CFP. FOV: 45 degrees.
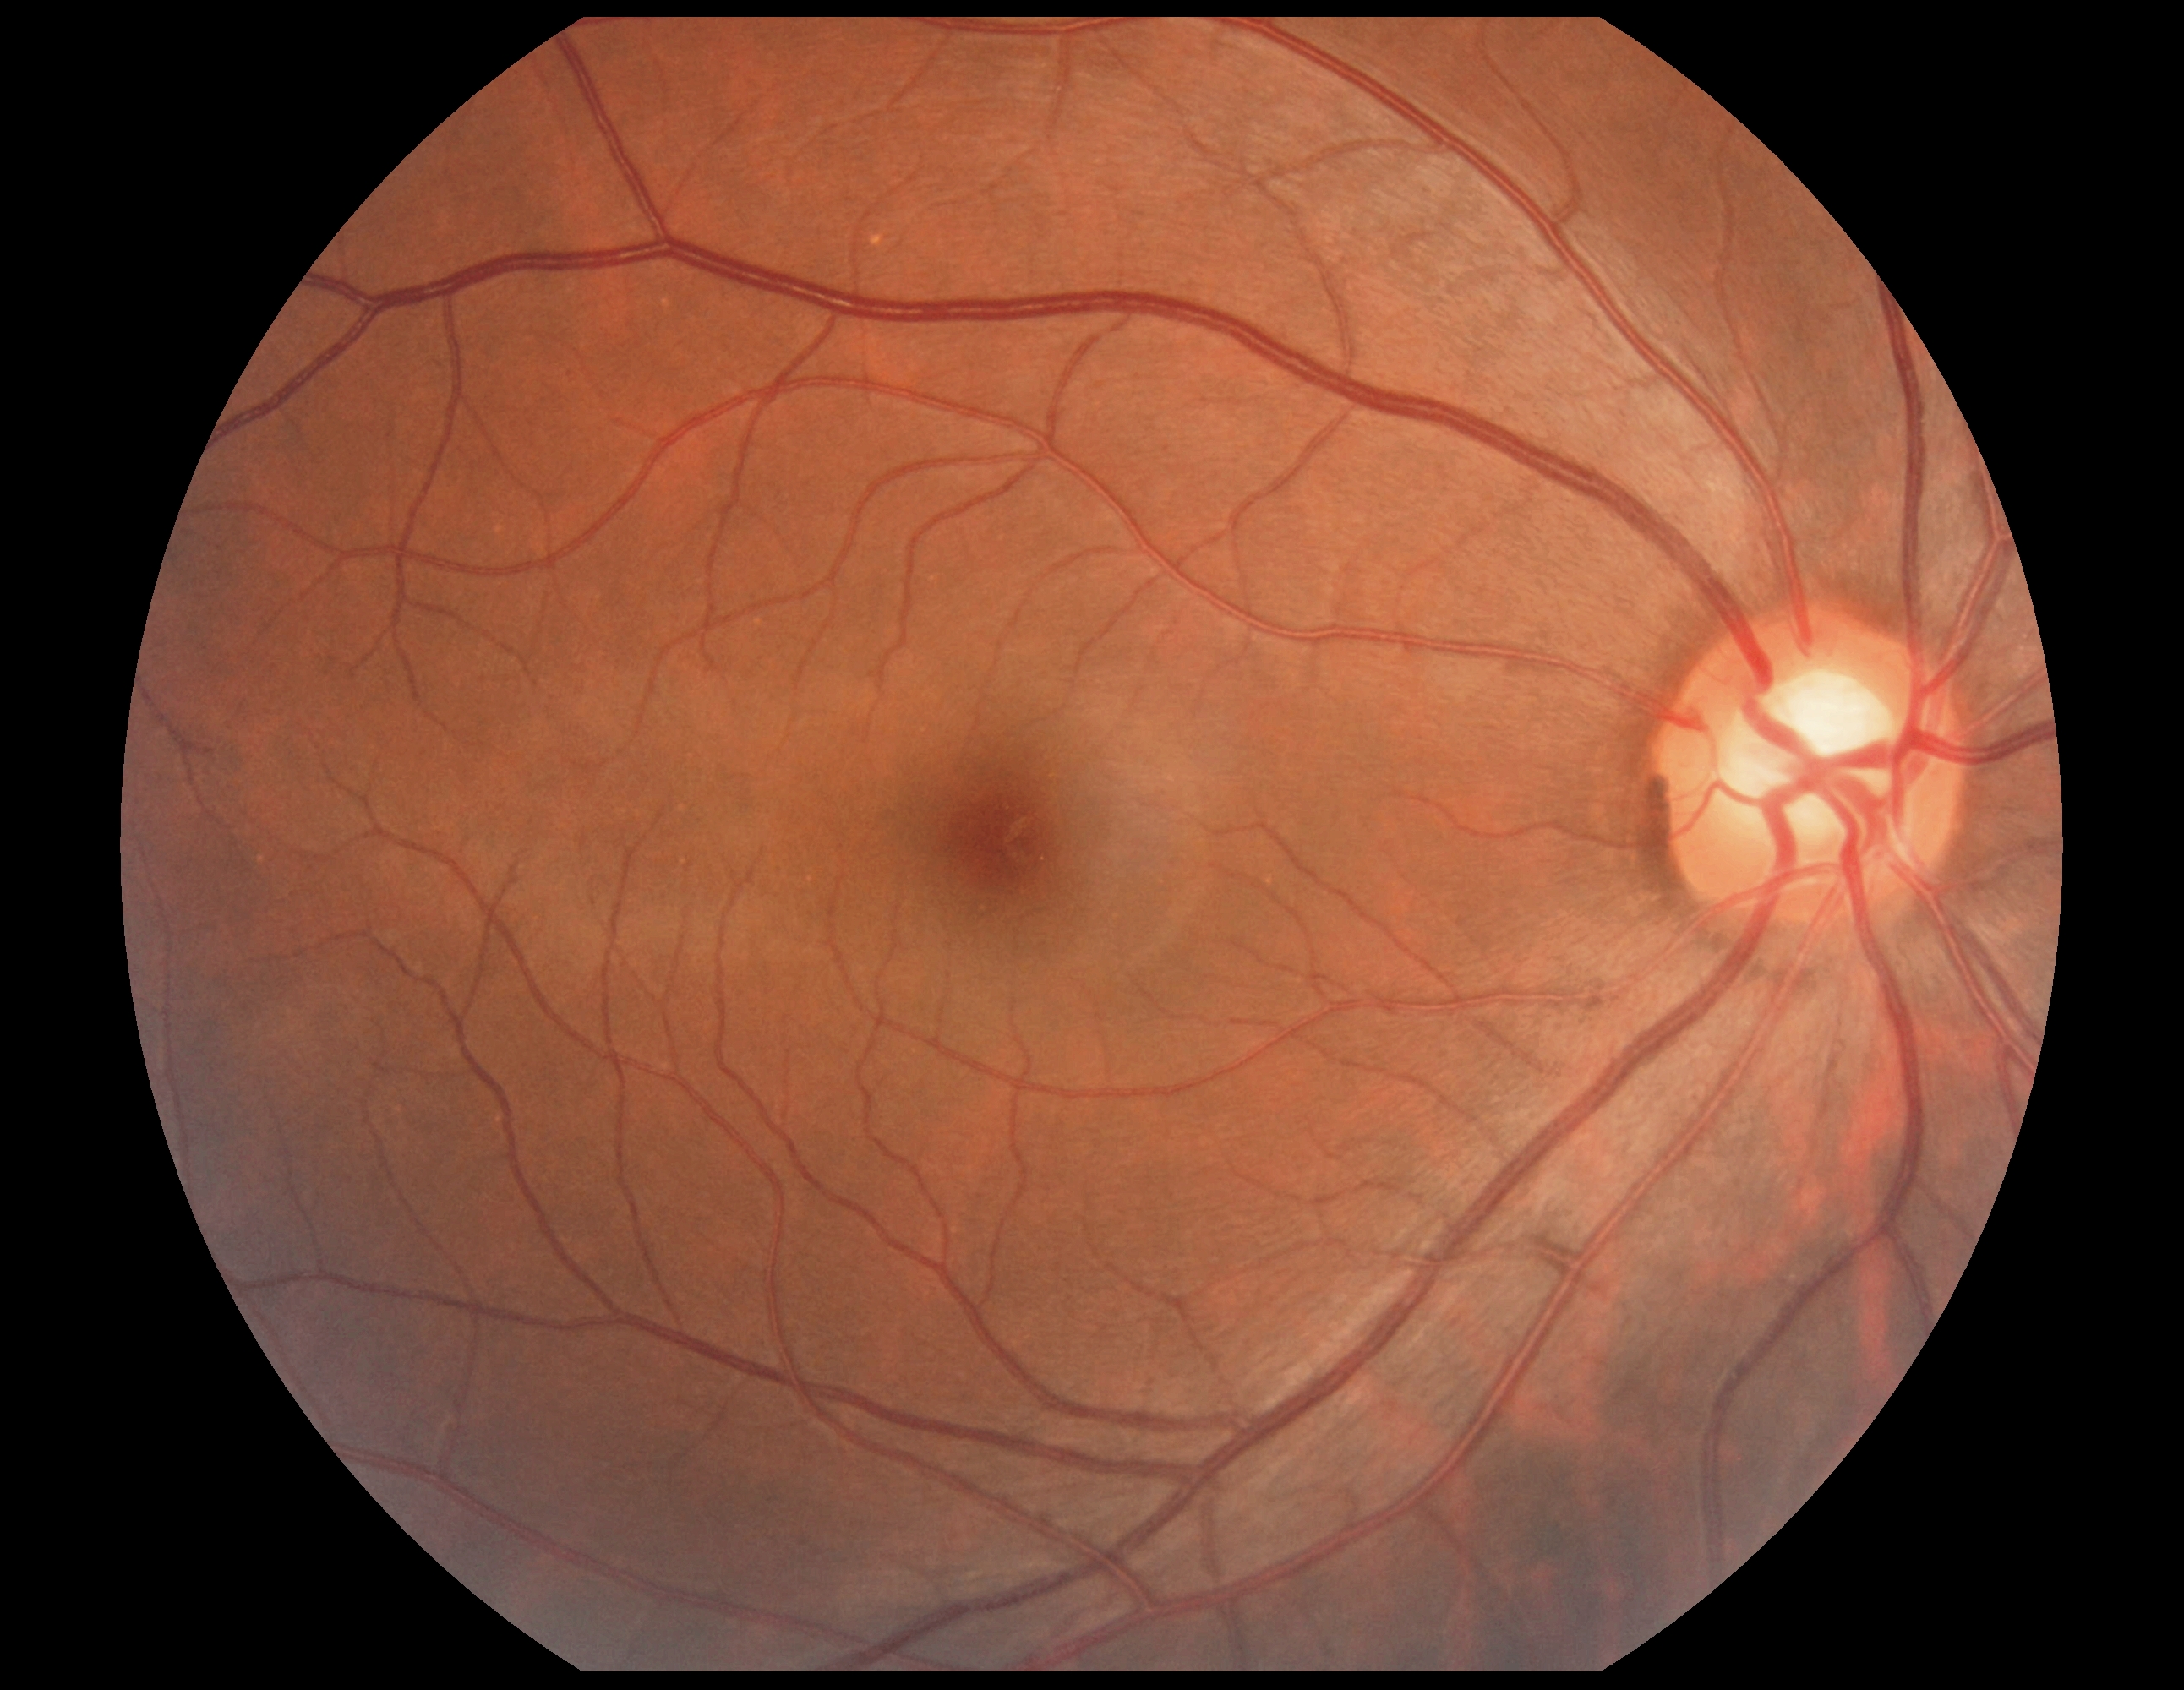
No signs of diabetic retinopathy. DR stage: 0.